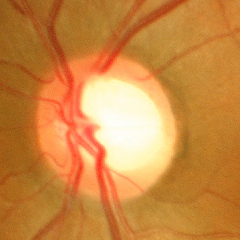
No signs of glaucoma.